Wide-field fundus image from infant ROP screening; 100° field of view (Phoenix ICON)
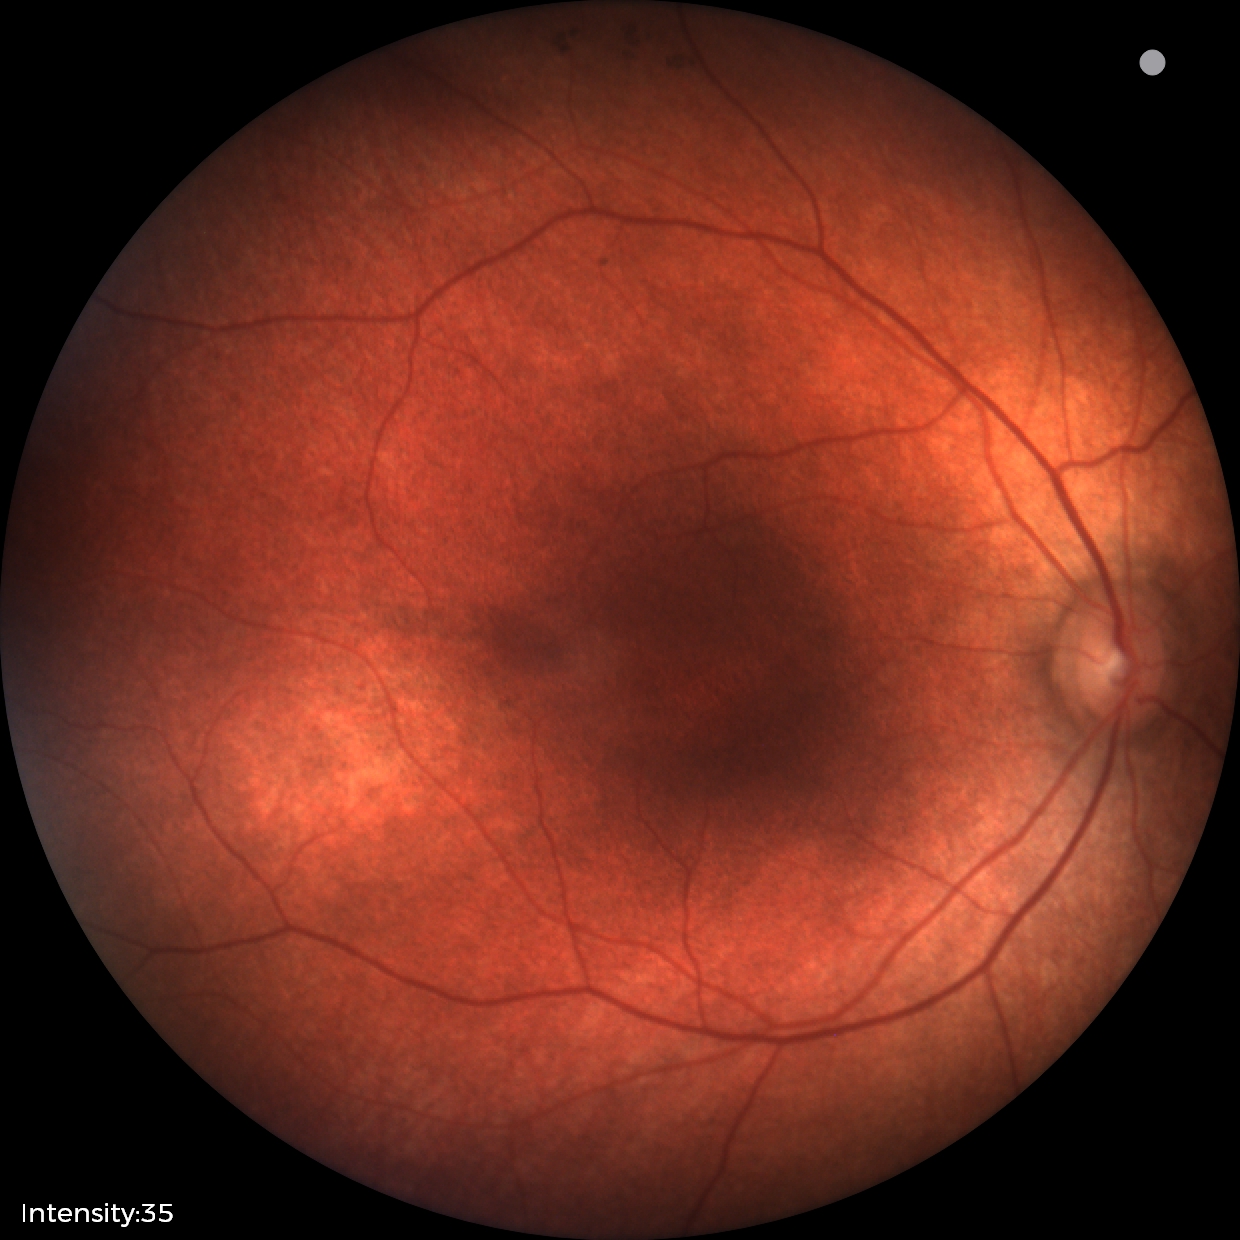 No retinal pathology identified on screening.